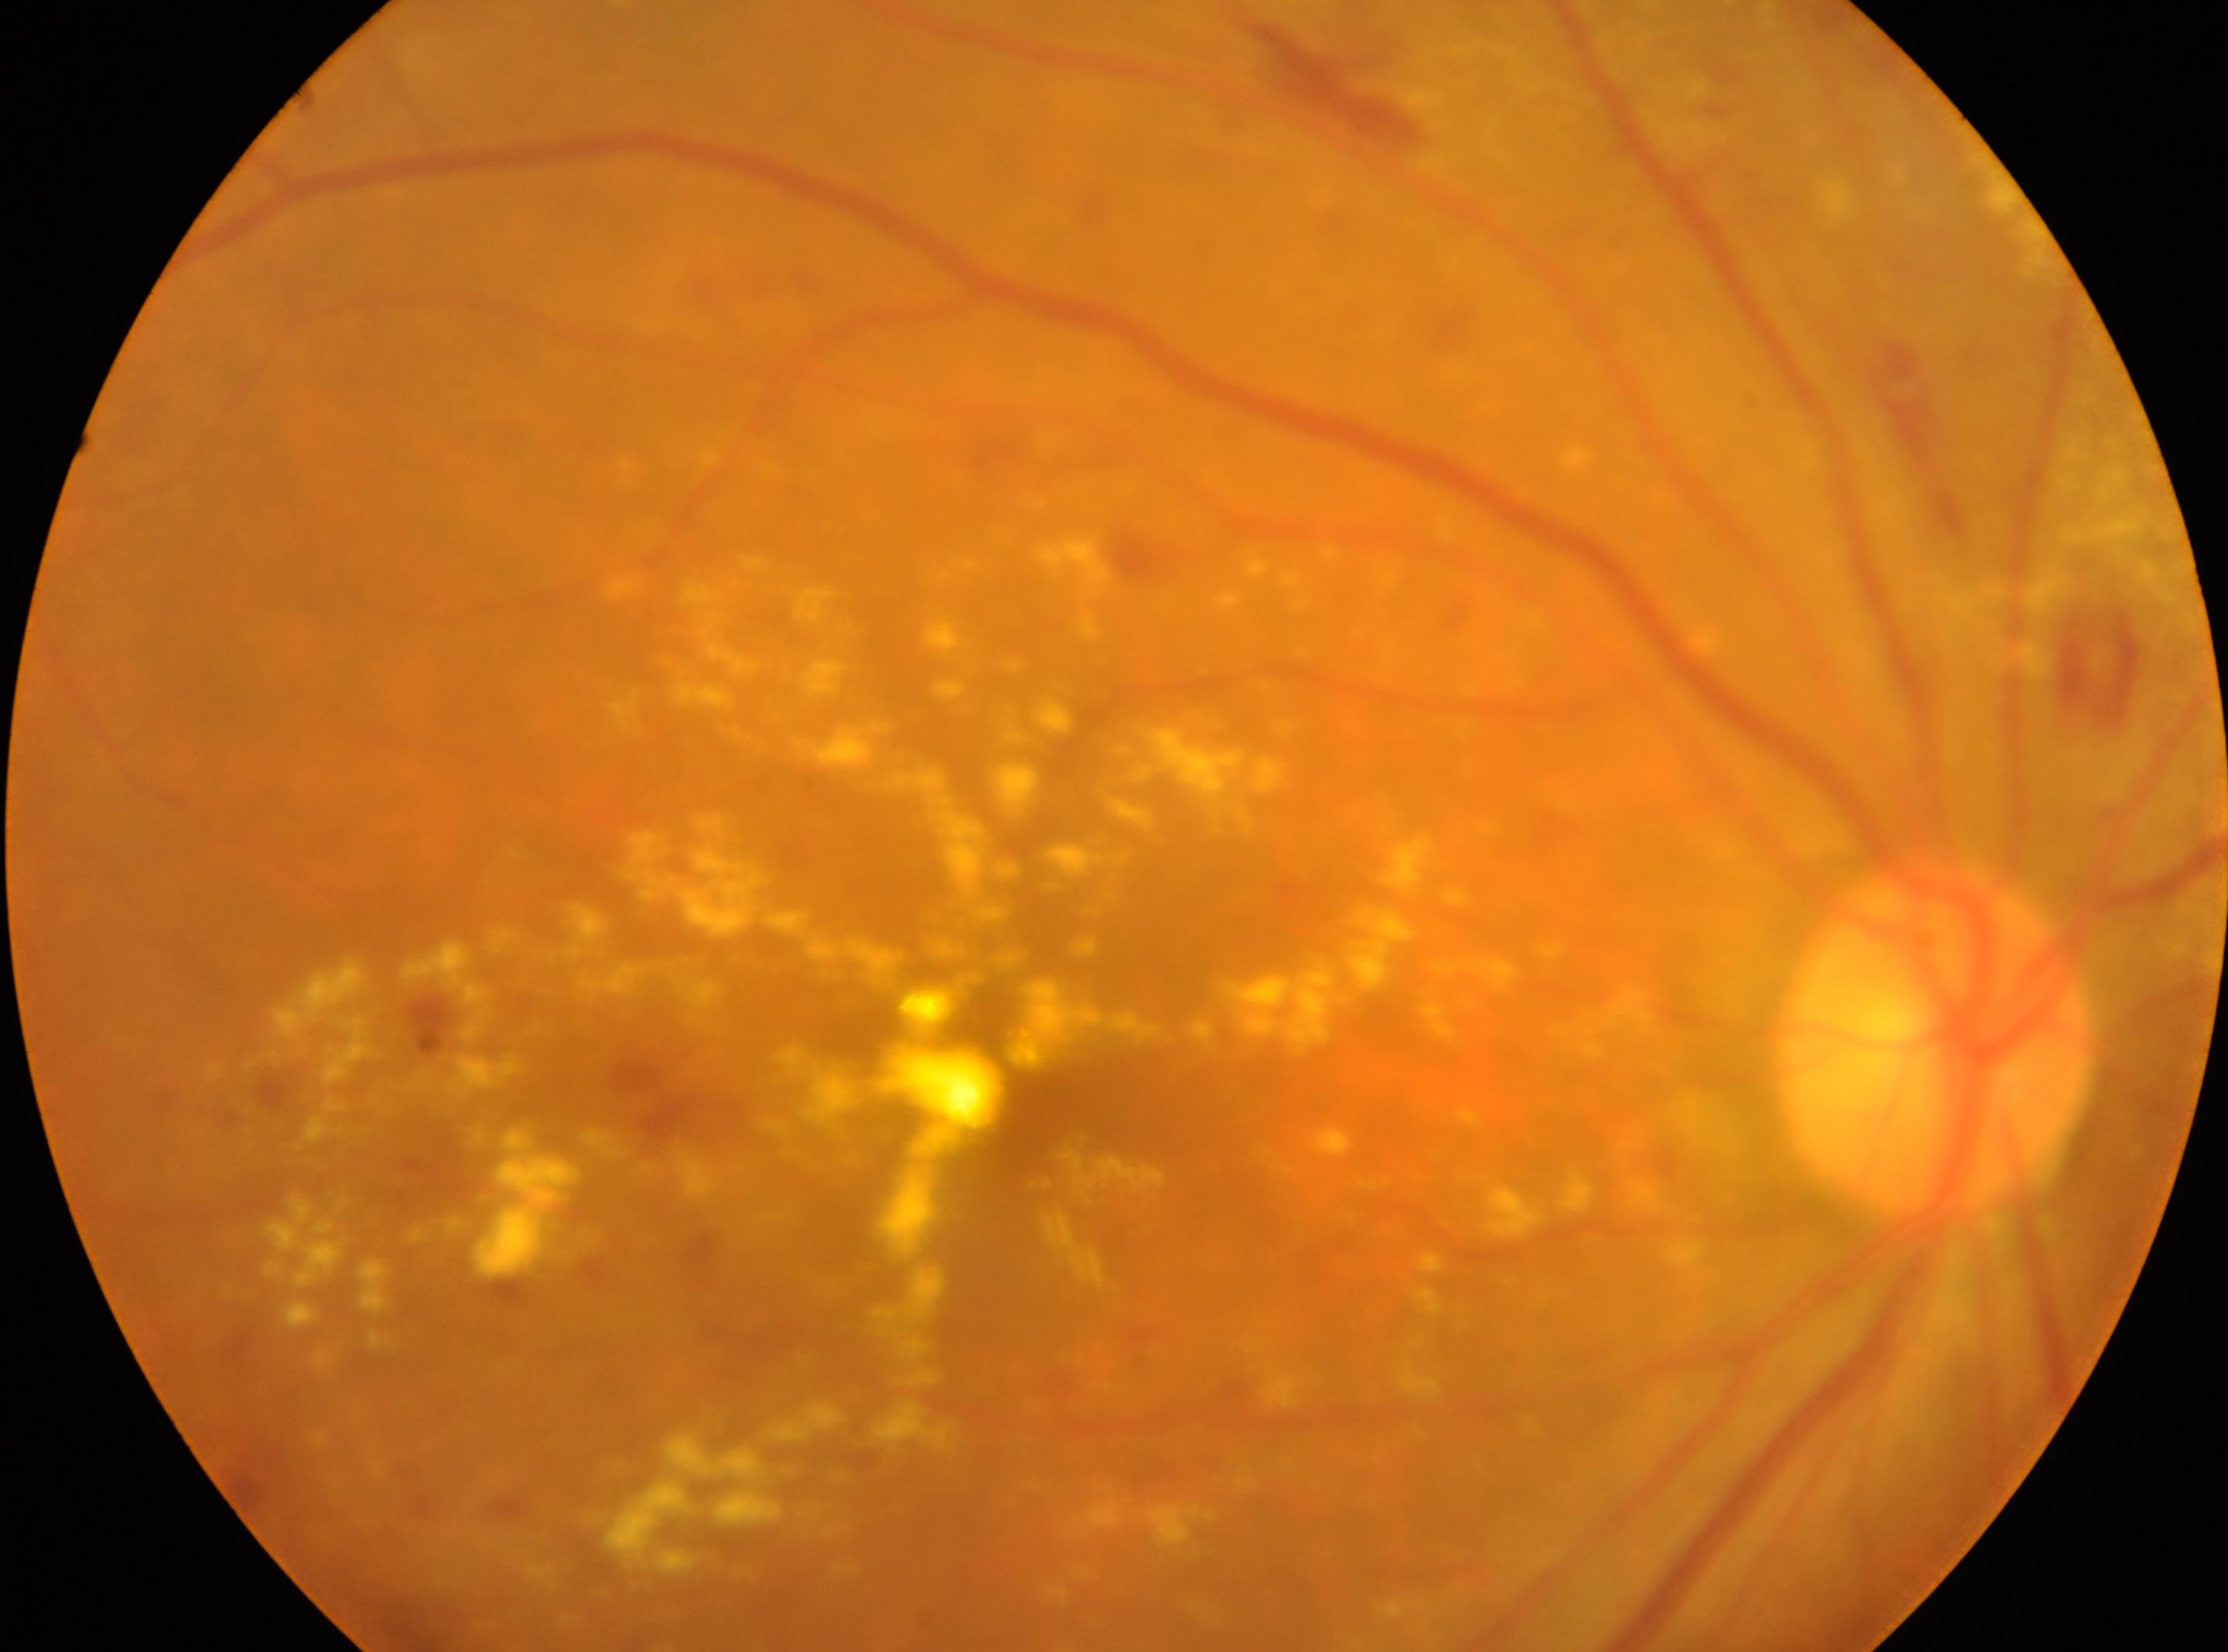
Optic nerve head located at 1934px, 1038px.
Retinopathy is grade 2.
DR class: non-proliferative diabetic retinopathy.
Imaged eye: OD.
The foveal center is at 1029px, 1098px.